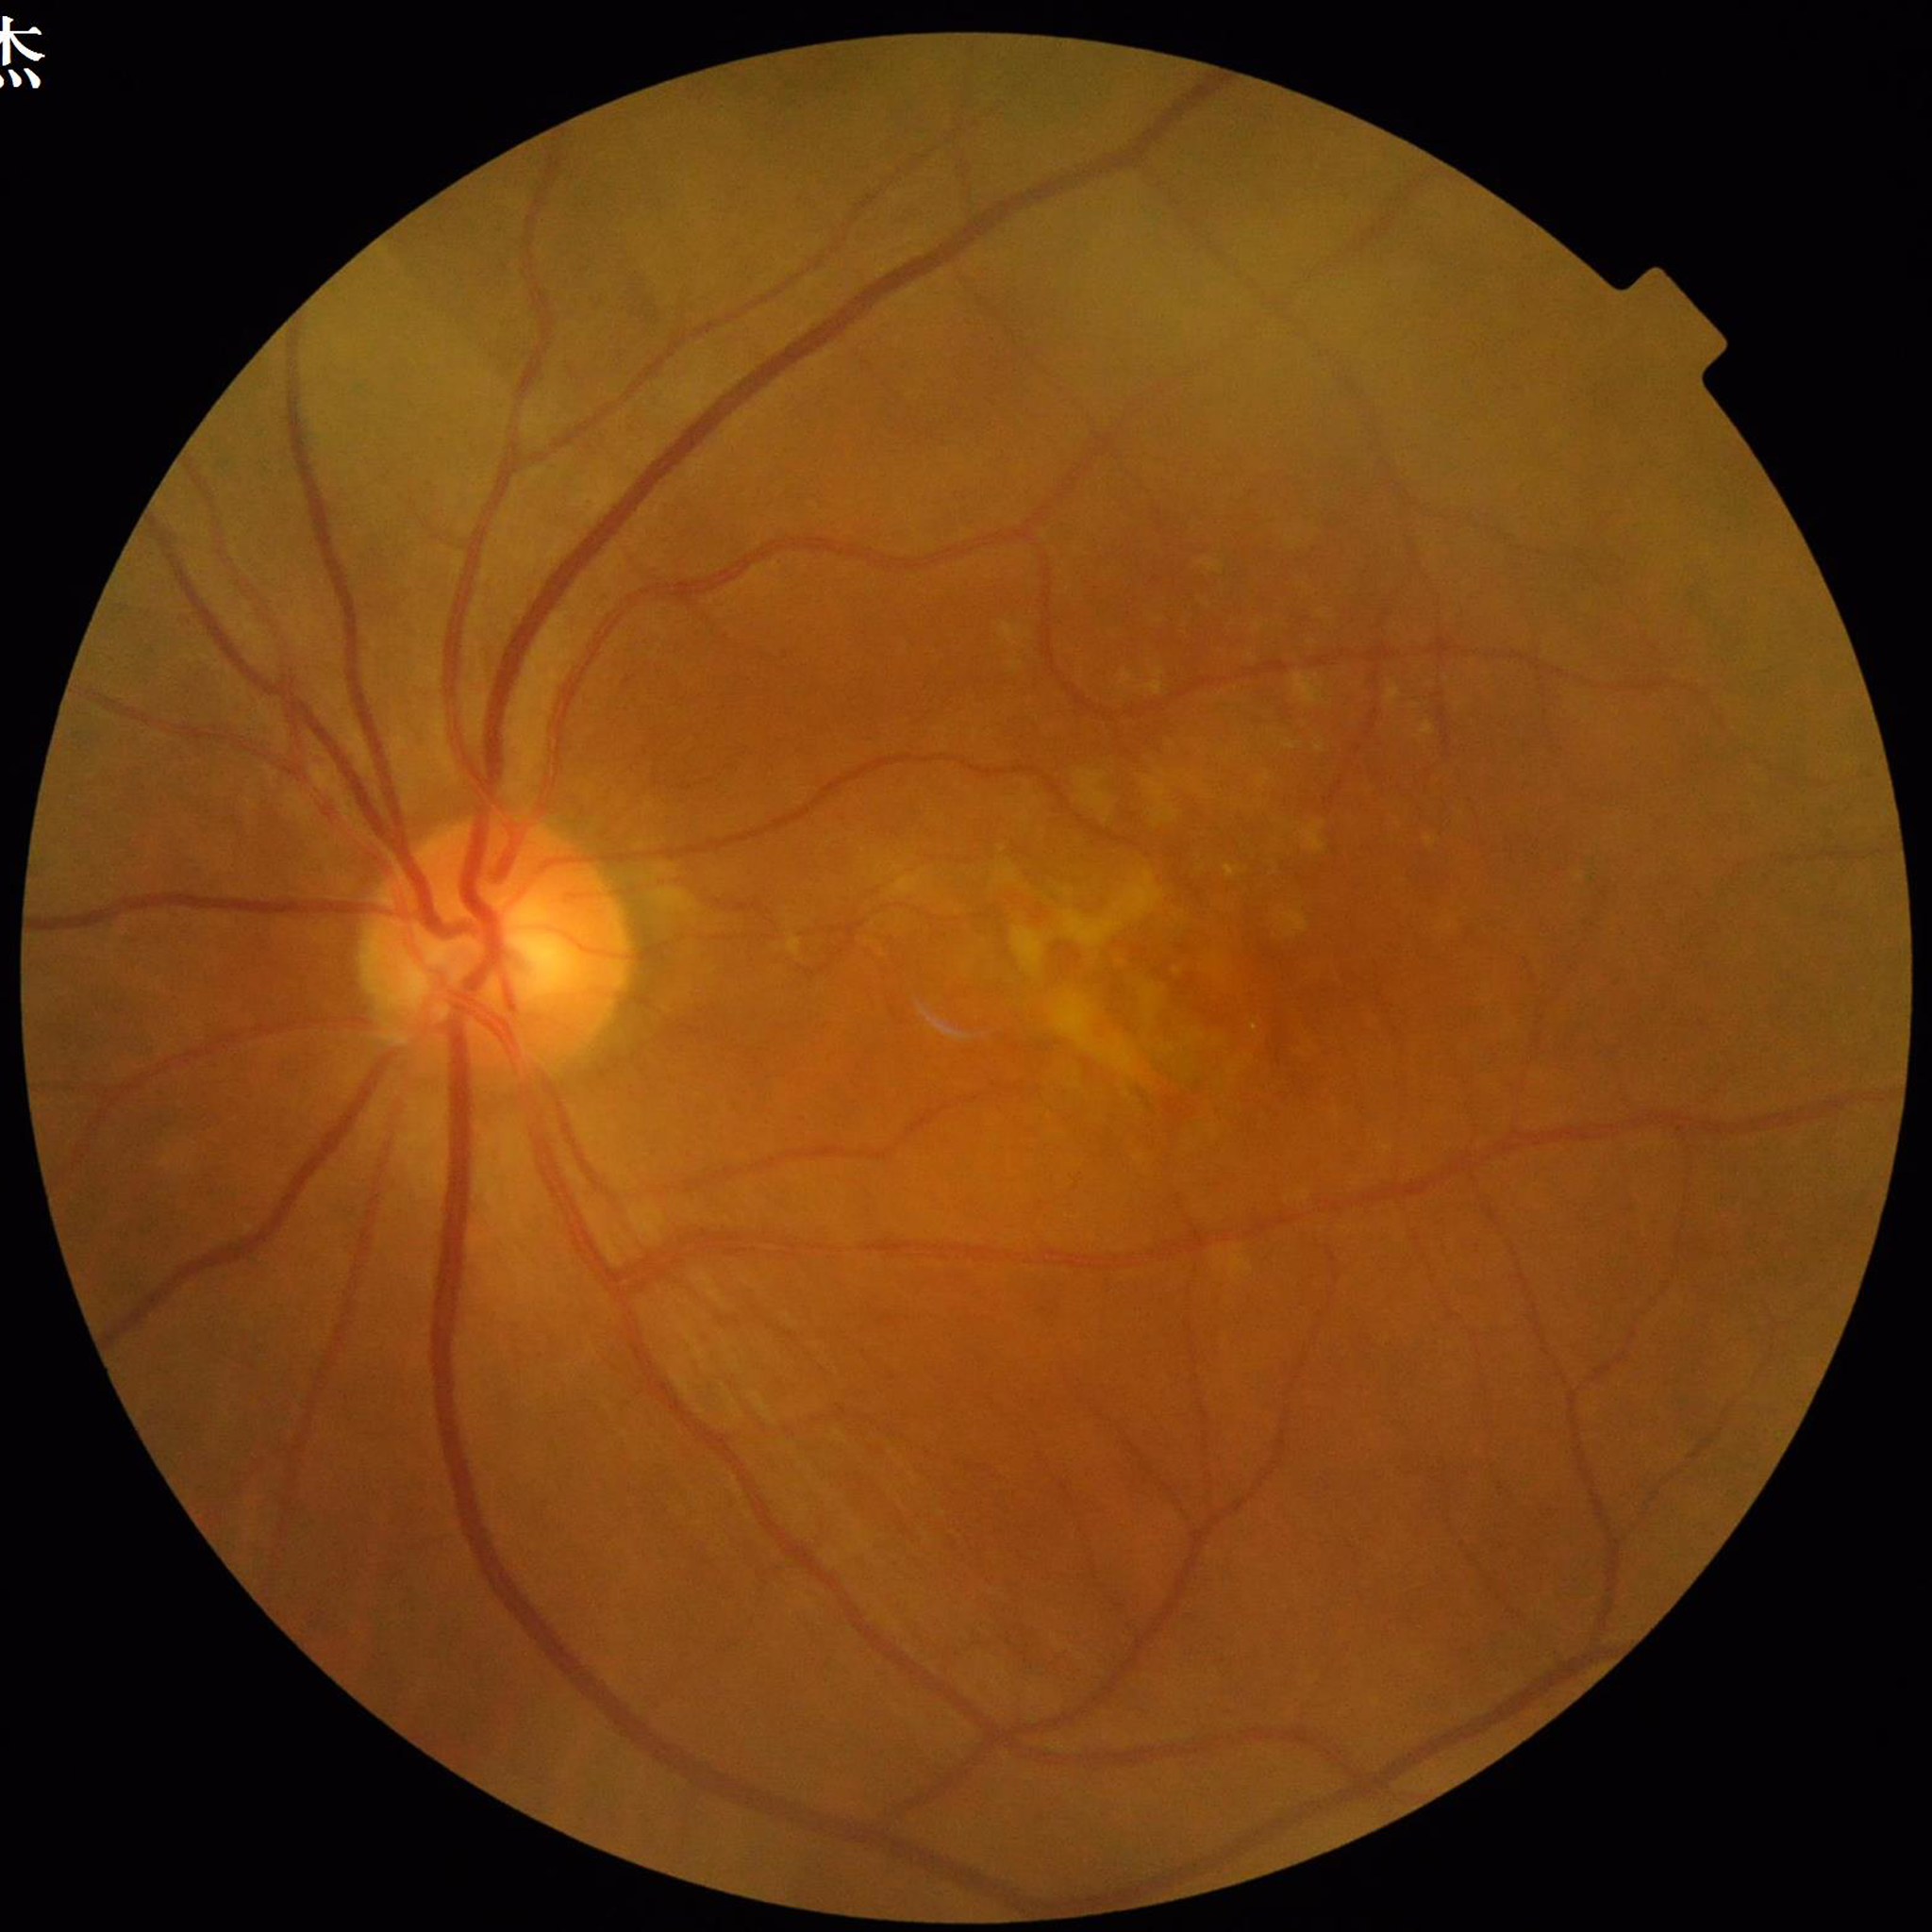
{"diagnosis": "AMD", "image_quality": "adequate"}